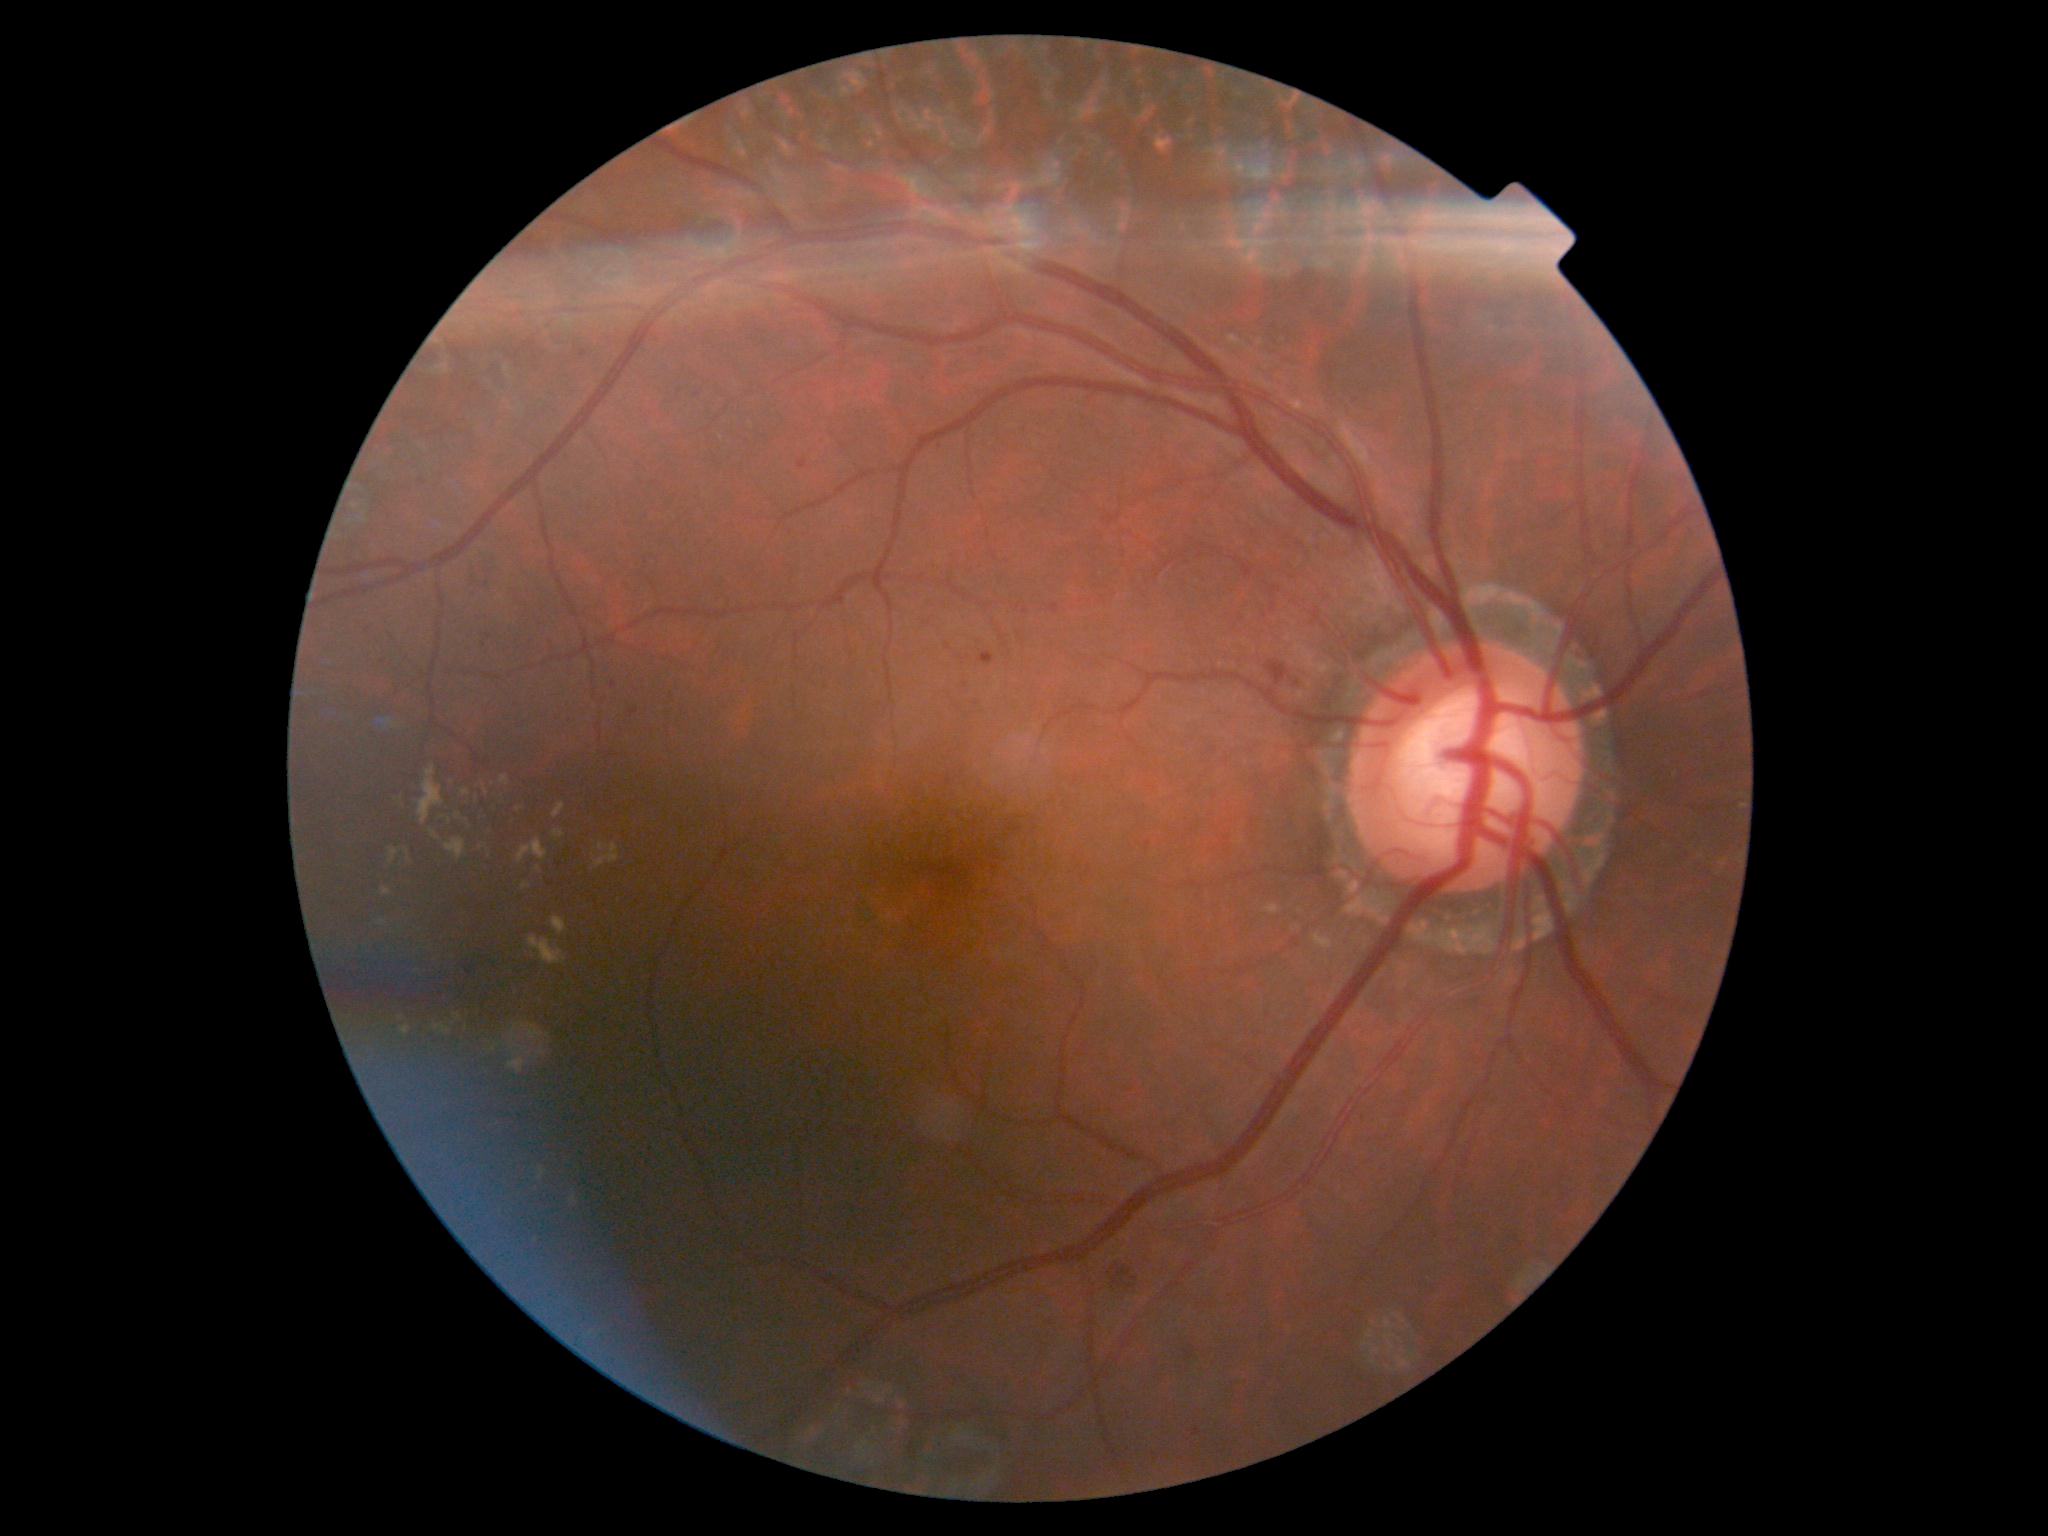
DR stage is grade 2.
EXs are present, including at bbox=[1228, 336, 1273, 362] | bbox=[462, 790, 471, 797] | bbox=[522, 884, 532, 891] | bbox=[509, 1025, 528, 1075] | bbox=[402, 1026, 410, 1035] | bbox=[521, 1025, 544, 1041] | bbox=[382, 889, 392, 897] | bbox=[538, 1168, 547, 1181] | bbox=[595, 844, 620, 869] | bbox=[389, 848, 399, 864] | bbox=[455, 1014, 462, 1022] | bbox=[552, 917, 568, 936] | bbox=[430, 830, 439, 840].
Small EXs near (535,1044) | (539,870) | (457,816) | (401,1019).